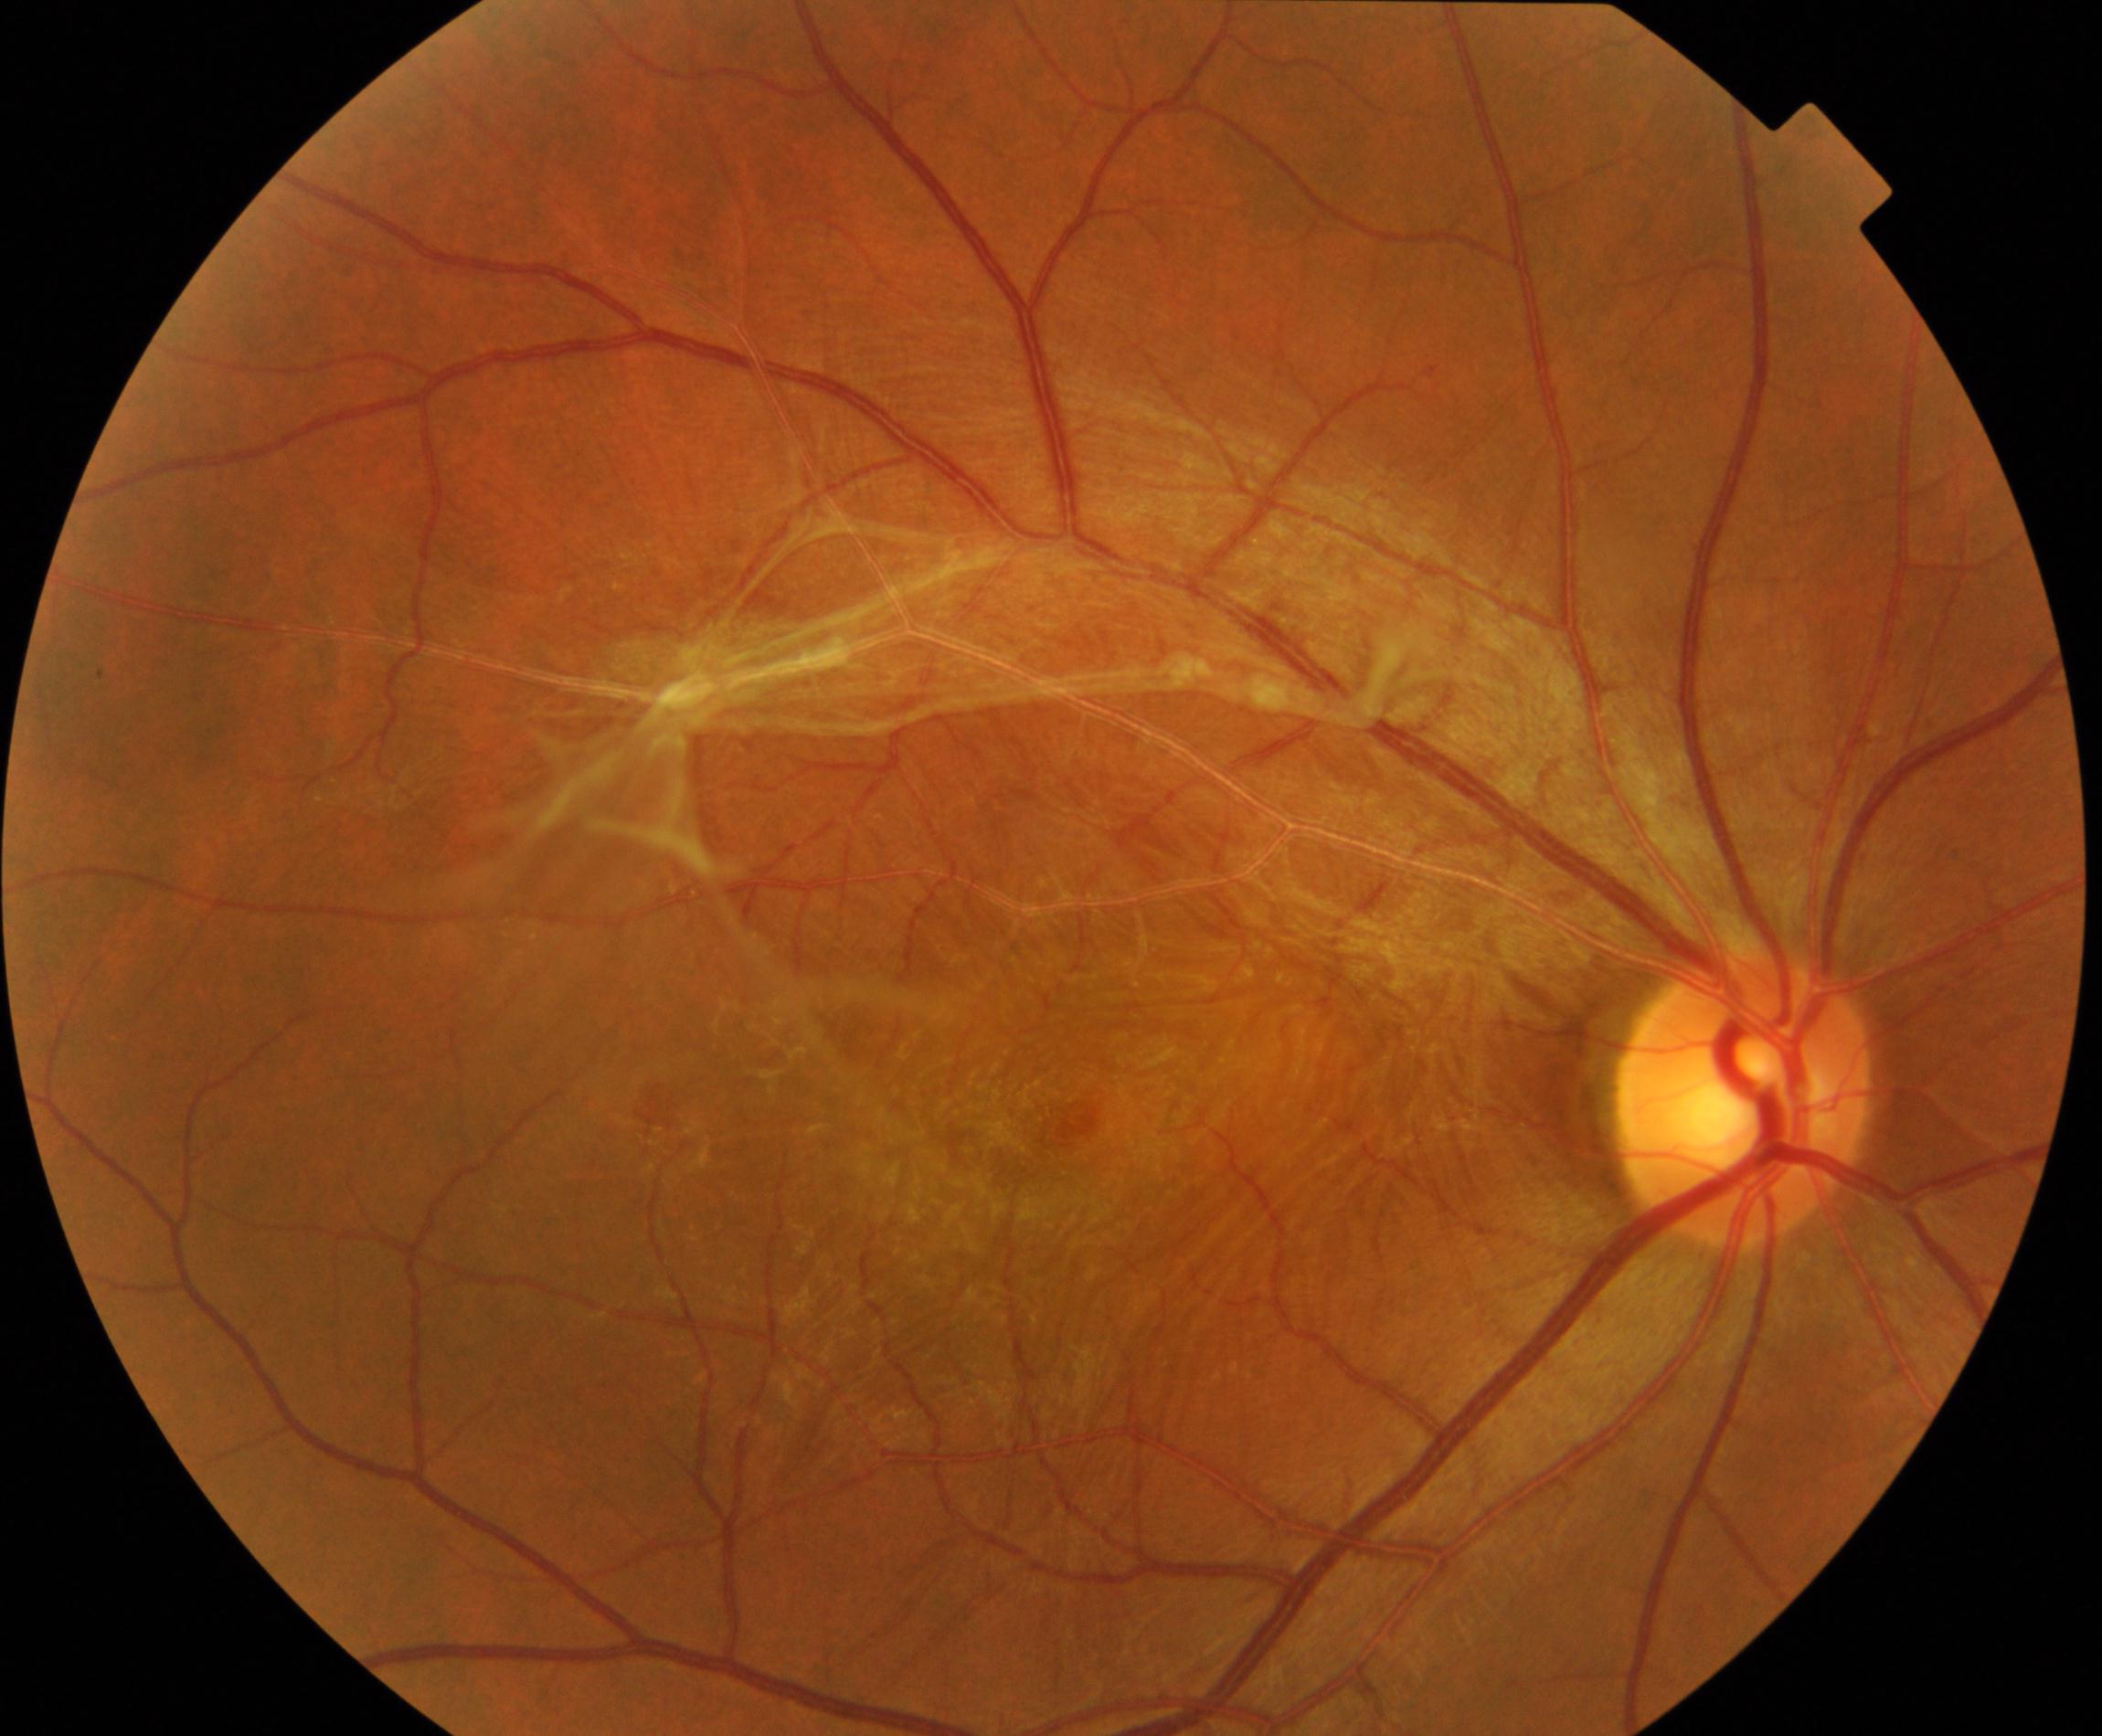 Findings: fibrosis.